45° FOV; 1932 x 1916 pixels; retinal fundus photograph: 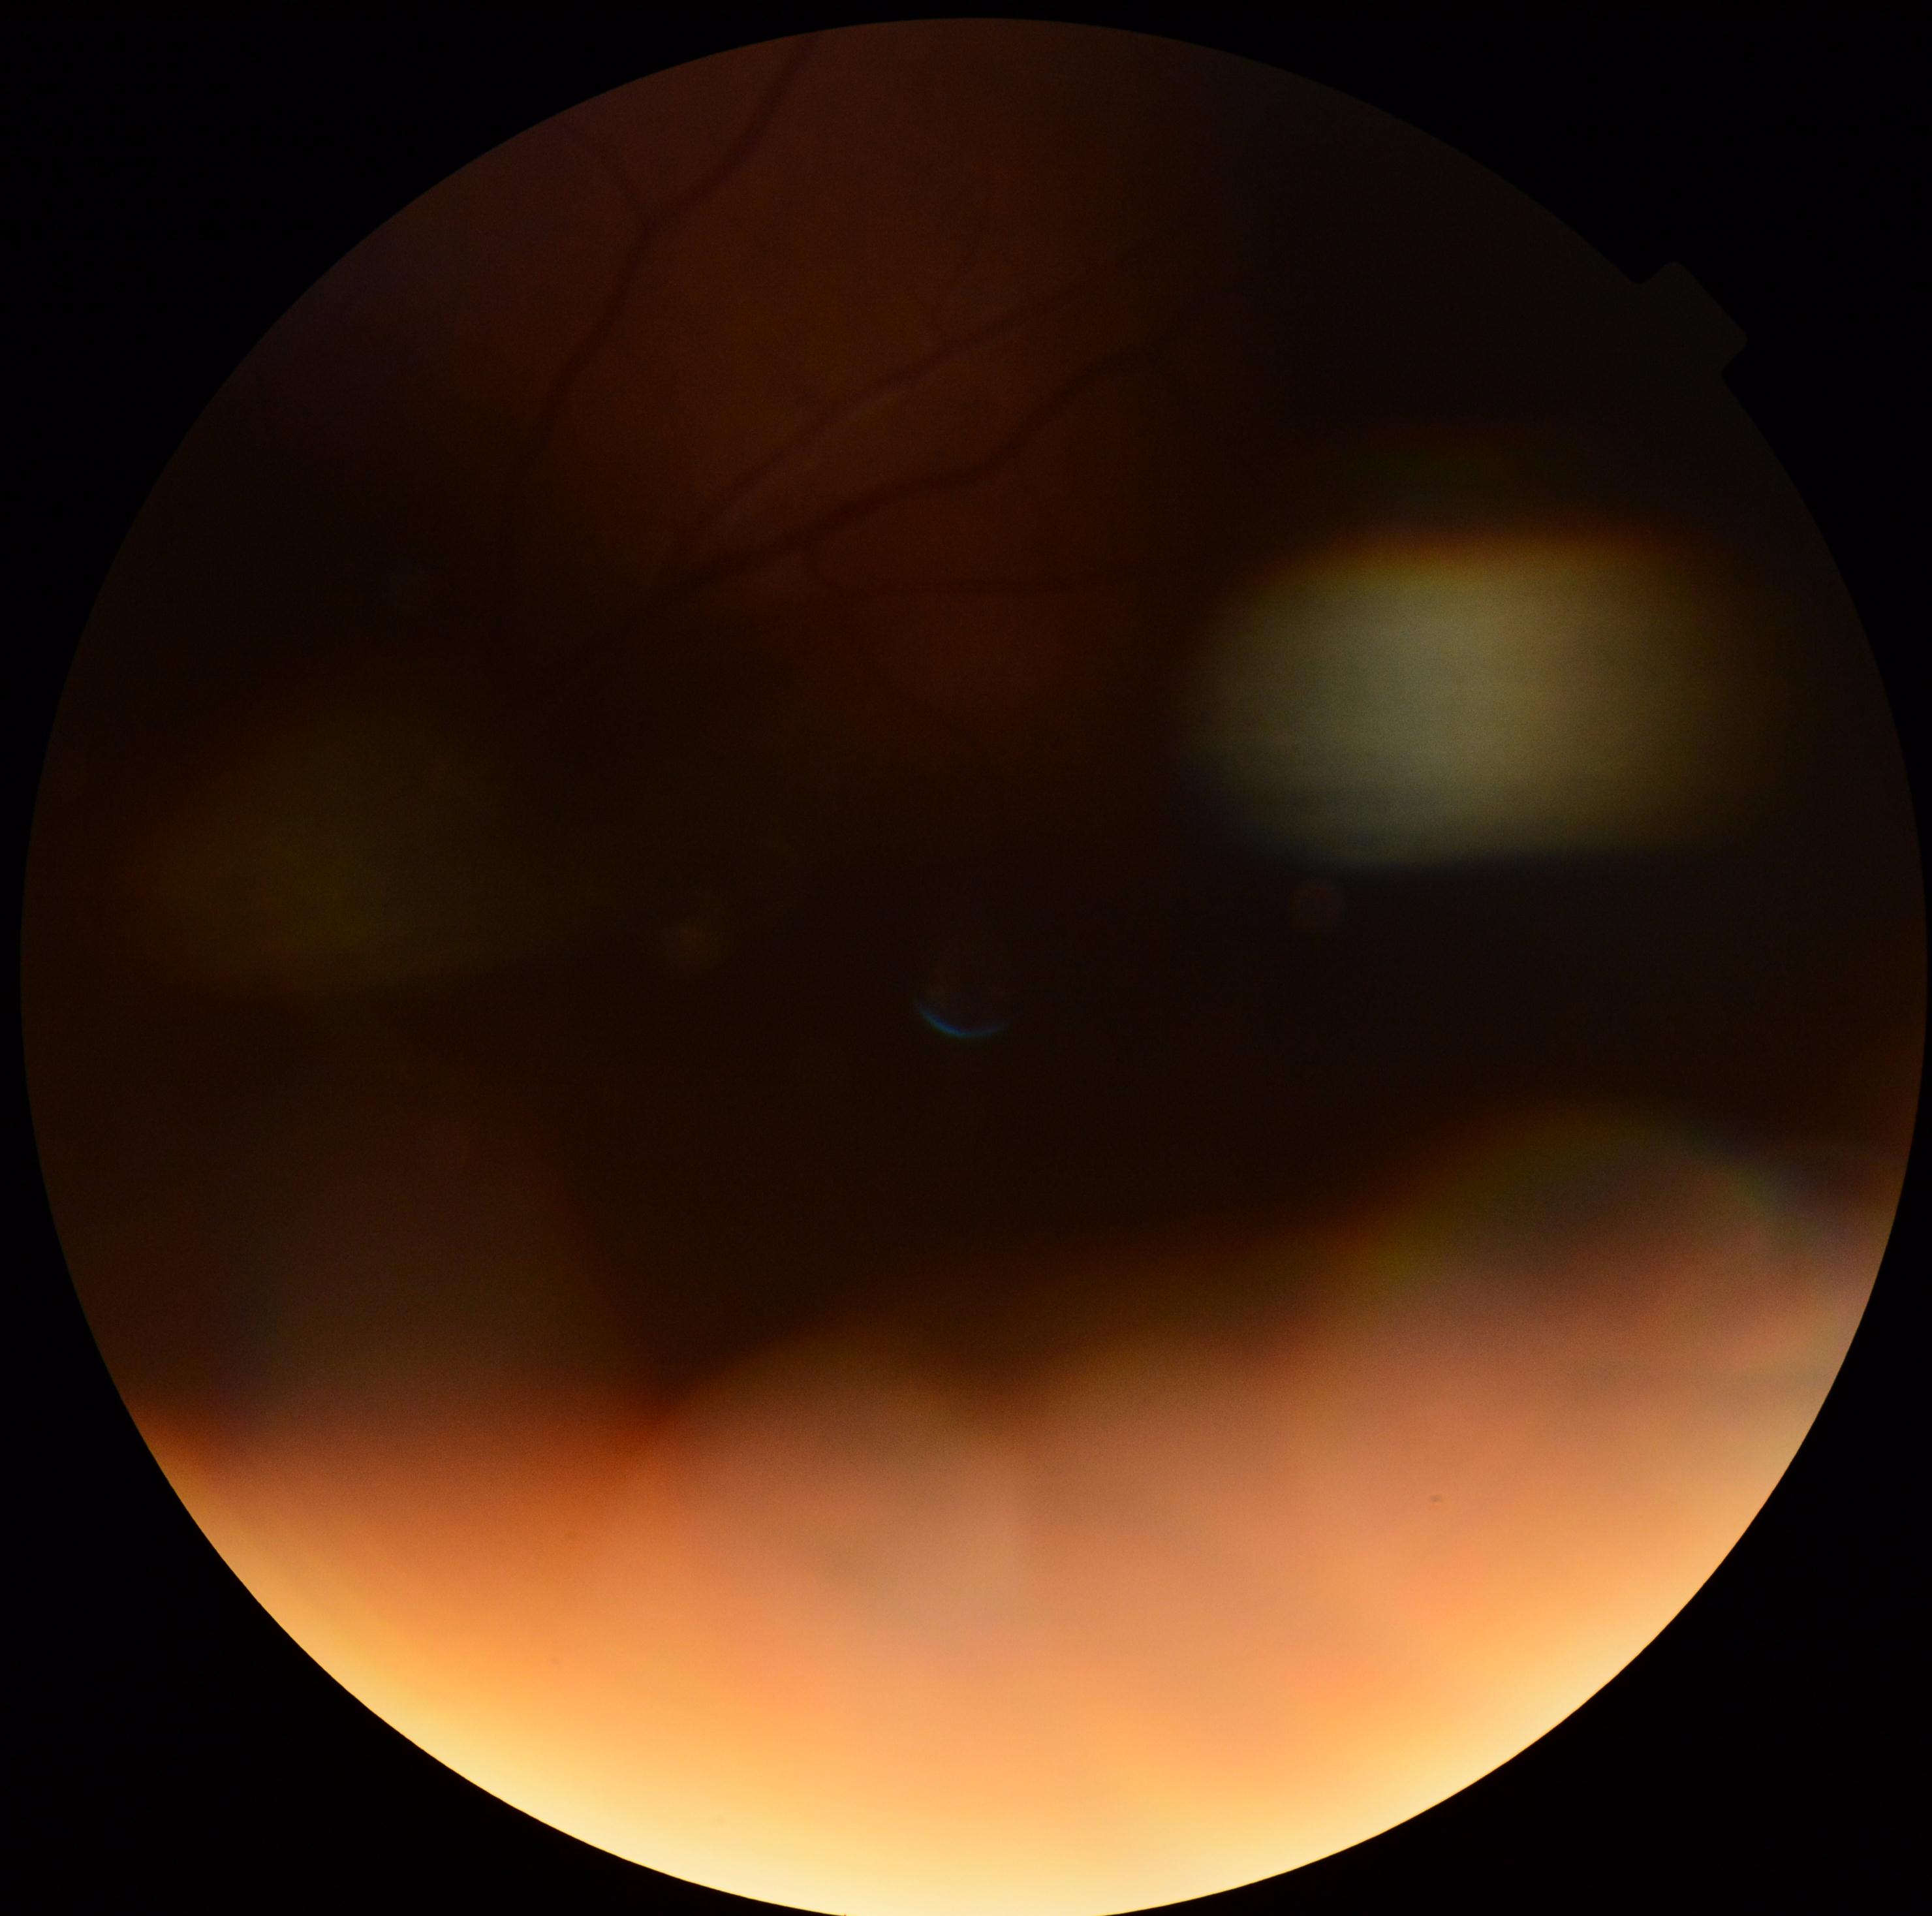
DR grade: ungradable; image quality: below grading threshold.